Wide-field fundus image from infant ROP screening:
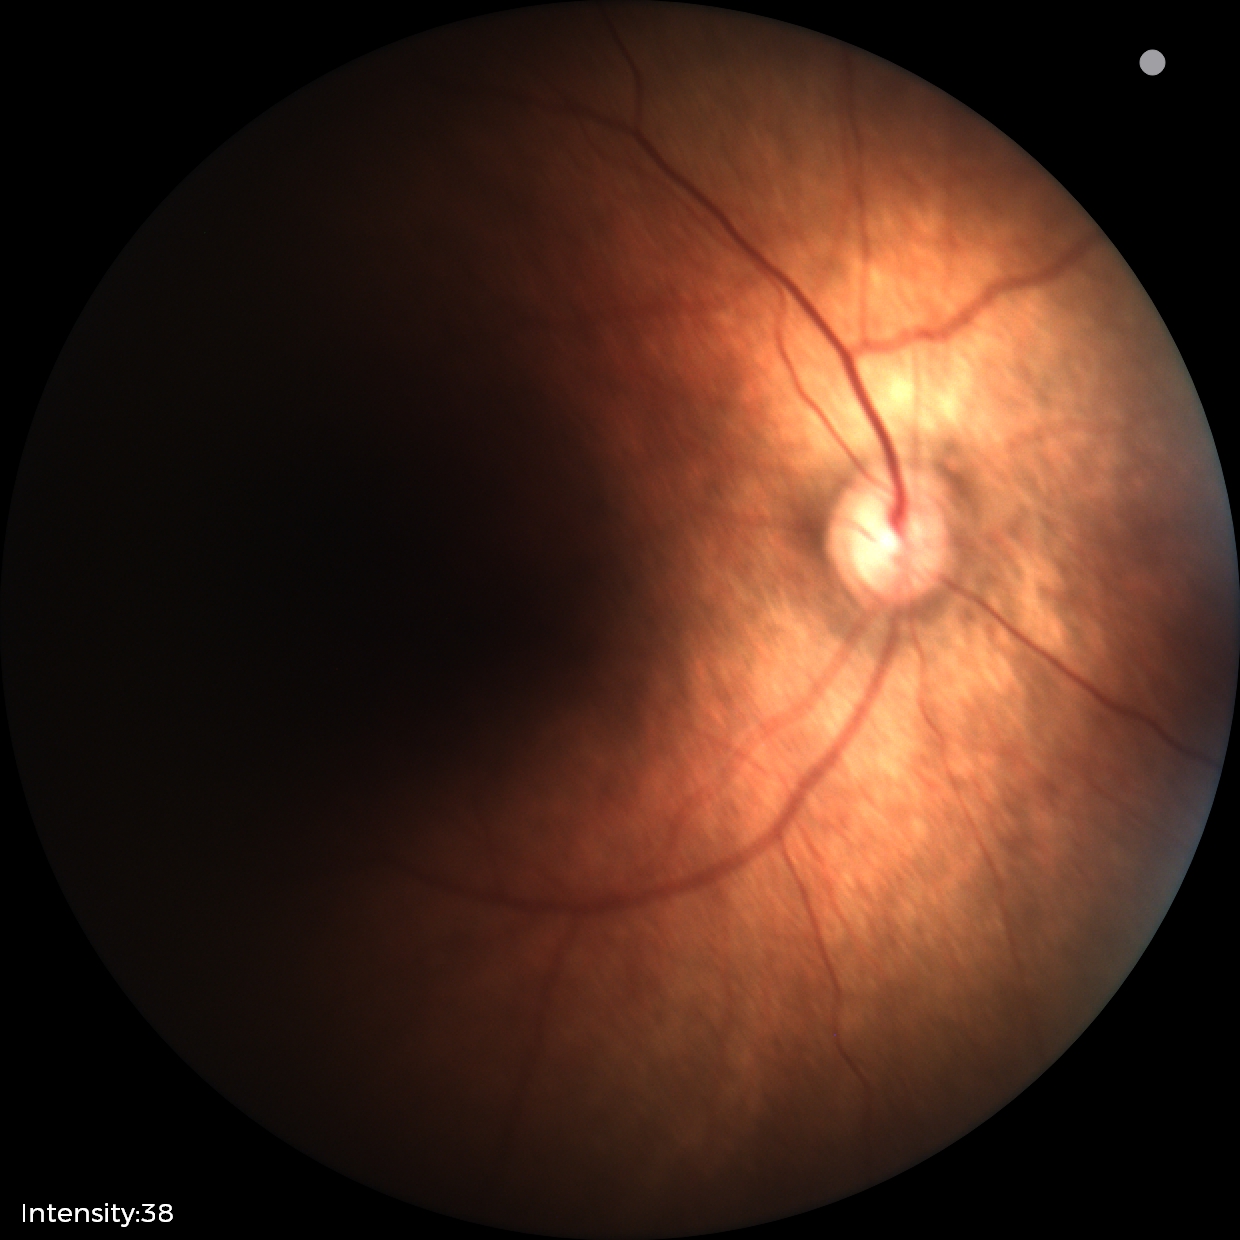 Normal screening examination.